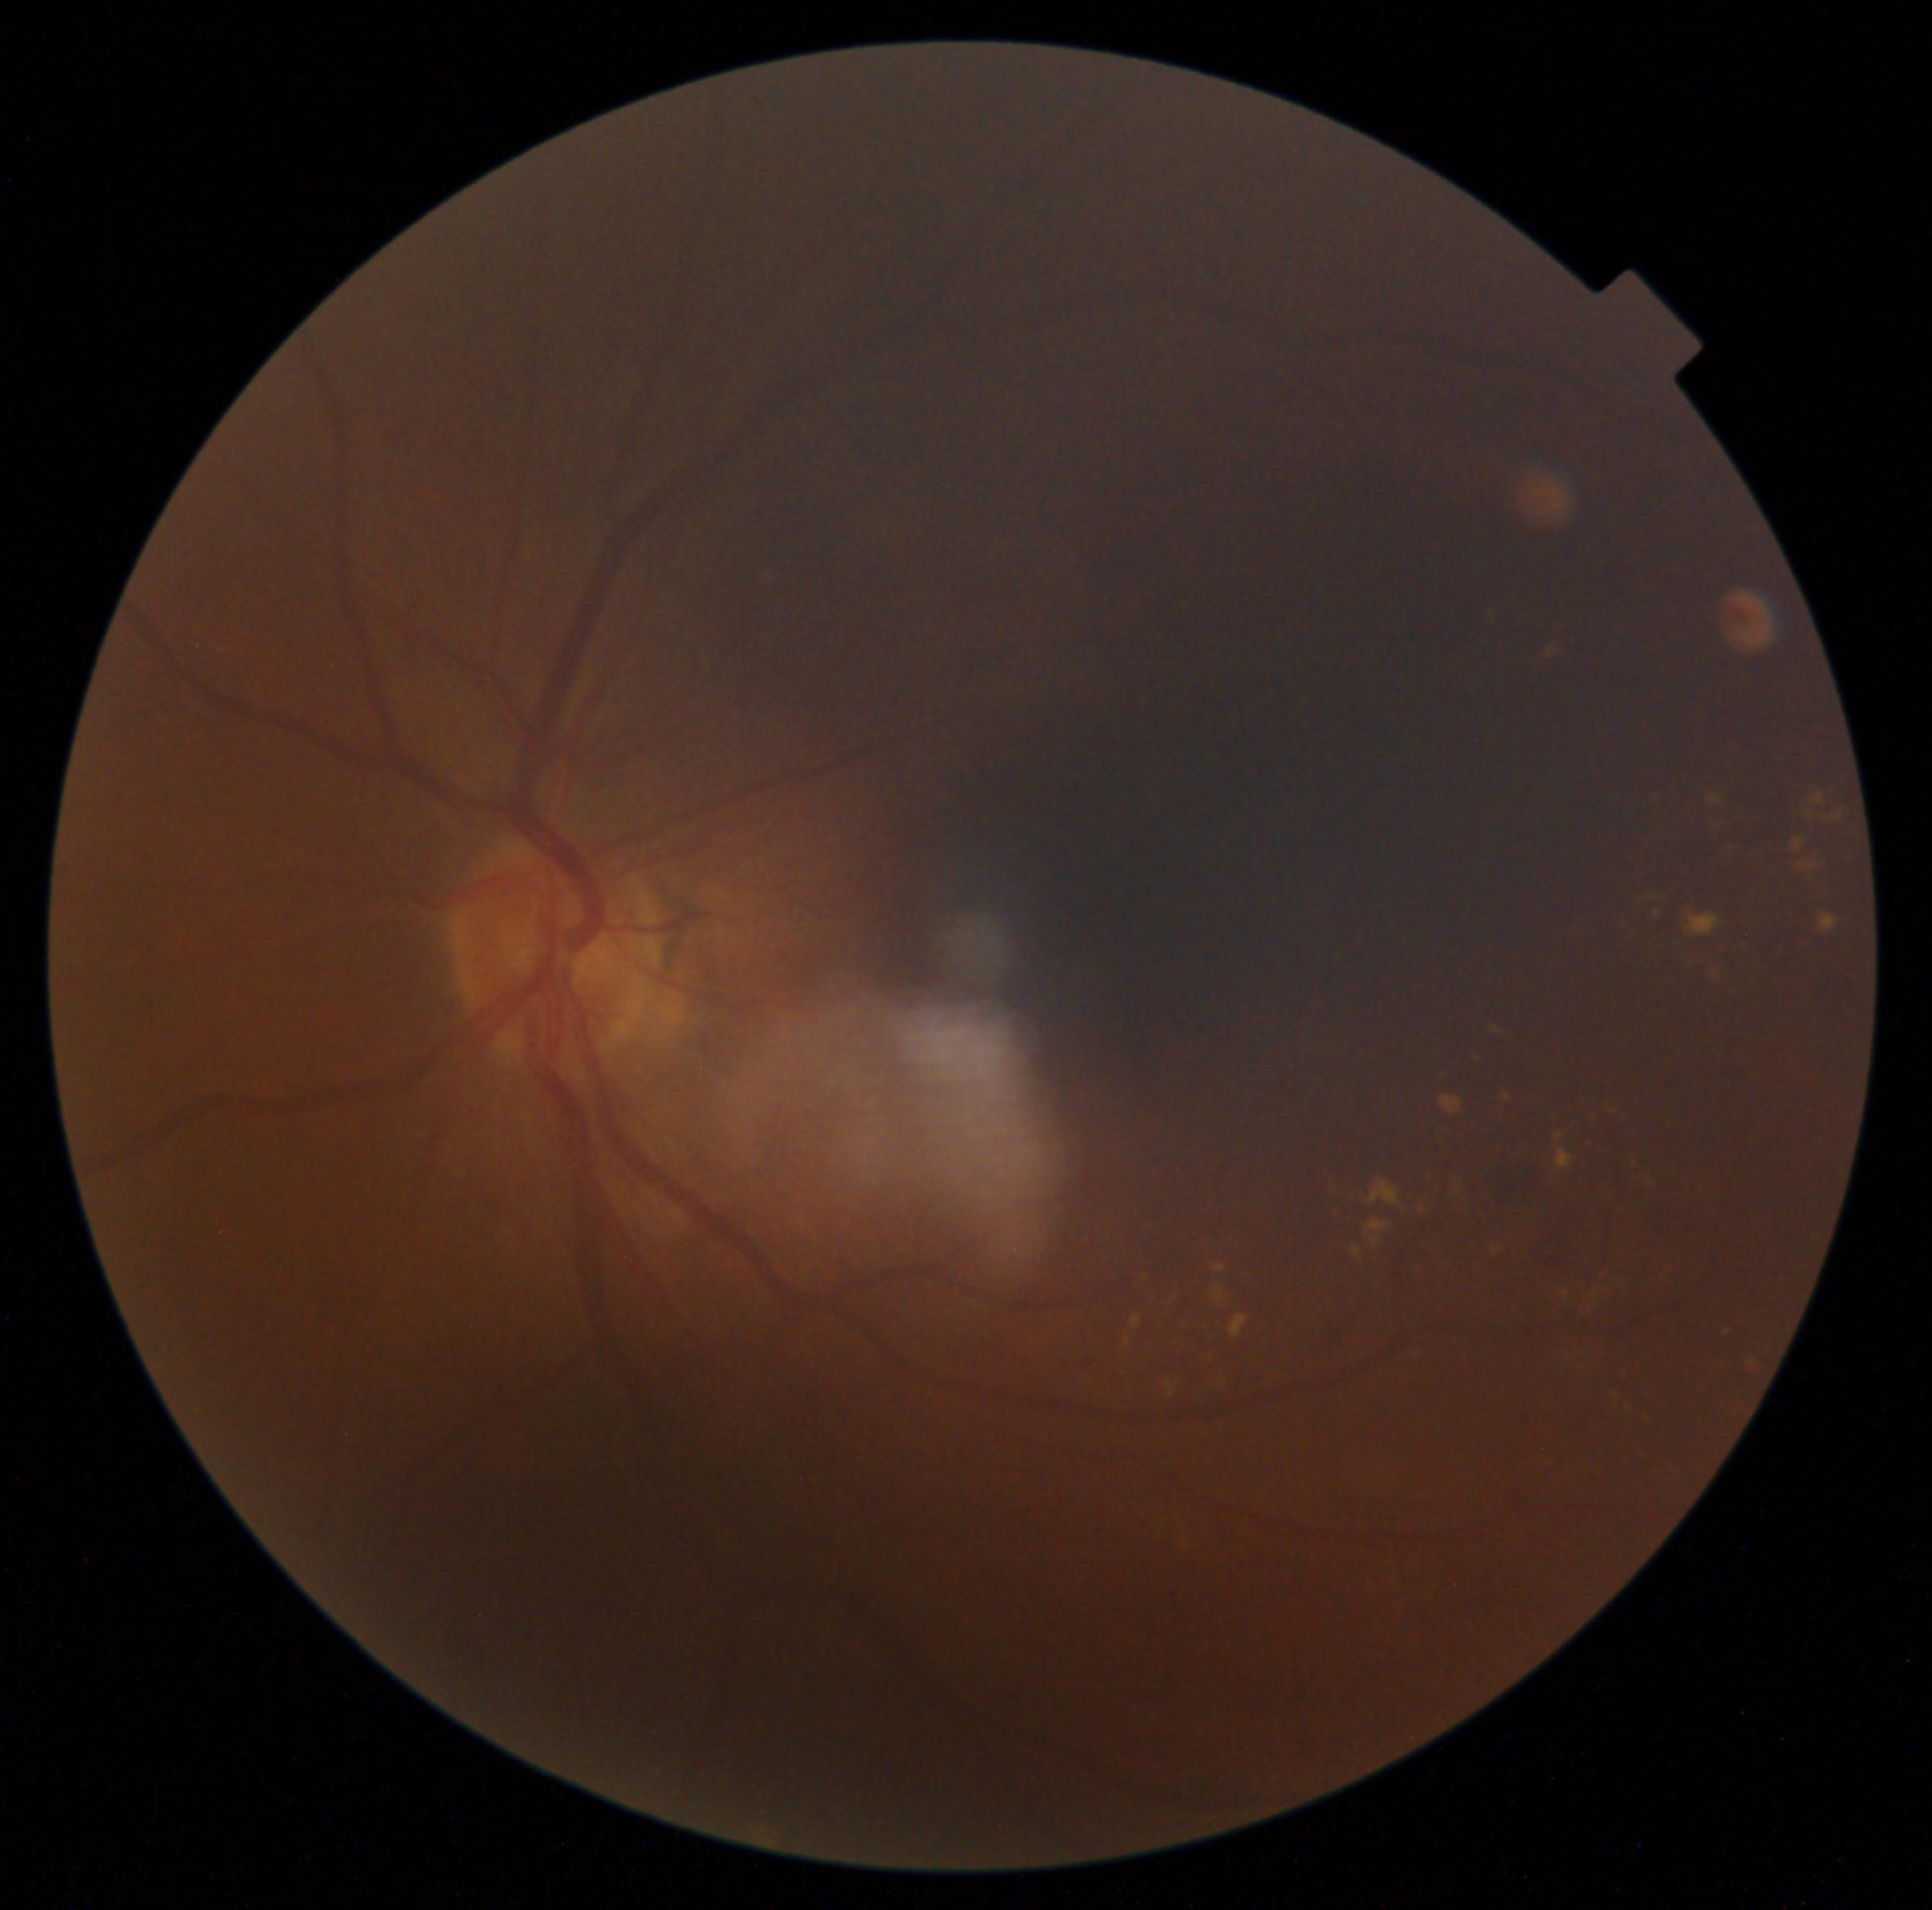

Diabetic retinopathy (DR) is grade 2 (moderate NPDR)
A subset of detected lesions:
soft exudates (SEs) = absent
hard exudates (EXs) (partial) = Rect(1576, 1272, 1623, 1321); Rect(1630, 892, 1672, 906); Rect(1515, 1090, 1529, 1103); Rect(1658, 1262, 1673, 1286); Rect(1800, 863, 1819, 870); Rect(1626, 1160, 1637, 1167); Rect(1610, 1392, 1623, 1404); Rect(1811, 793, 1825, 806); Rect(1725, 1327, 1735, 1341); Rect(1711, 797, 1722, 806); Rect(1126, 1338, 1132, 1347); Rect(1727, 1393, 1753, 1411); Rect(1485, 605, 1491, 621); Rect(1232, 1316, 1248, 1340); Rect(1799, 936, 1814, 949); Rect(1370, 1182, 1399, 1205); Rect(1809, 811, 1814, 822); Rect(1722, 848, 1744, 861)
Small EXs near 1497, 1253
hemorrhages (HEs) = Rect(1537, 1234, 1557, 1268); Rect(1653, 886, 1687, 931); Rect(1315, 1321, 1341, 1359); Rect(1078, 1349, 1095, 1367); Rect(1483, 1152, 1542, 1200); Rect(1460, 1567, 1513, 1618); Rect(1723, 1062, 1750, 1081); Rect(1517, 1402, 1531, 1417); Rect(1653, 826, 1702, 892)
microaneurysms (MAs) = absent